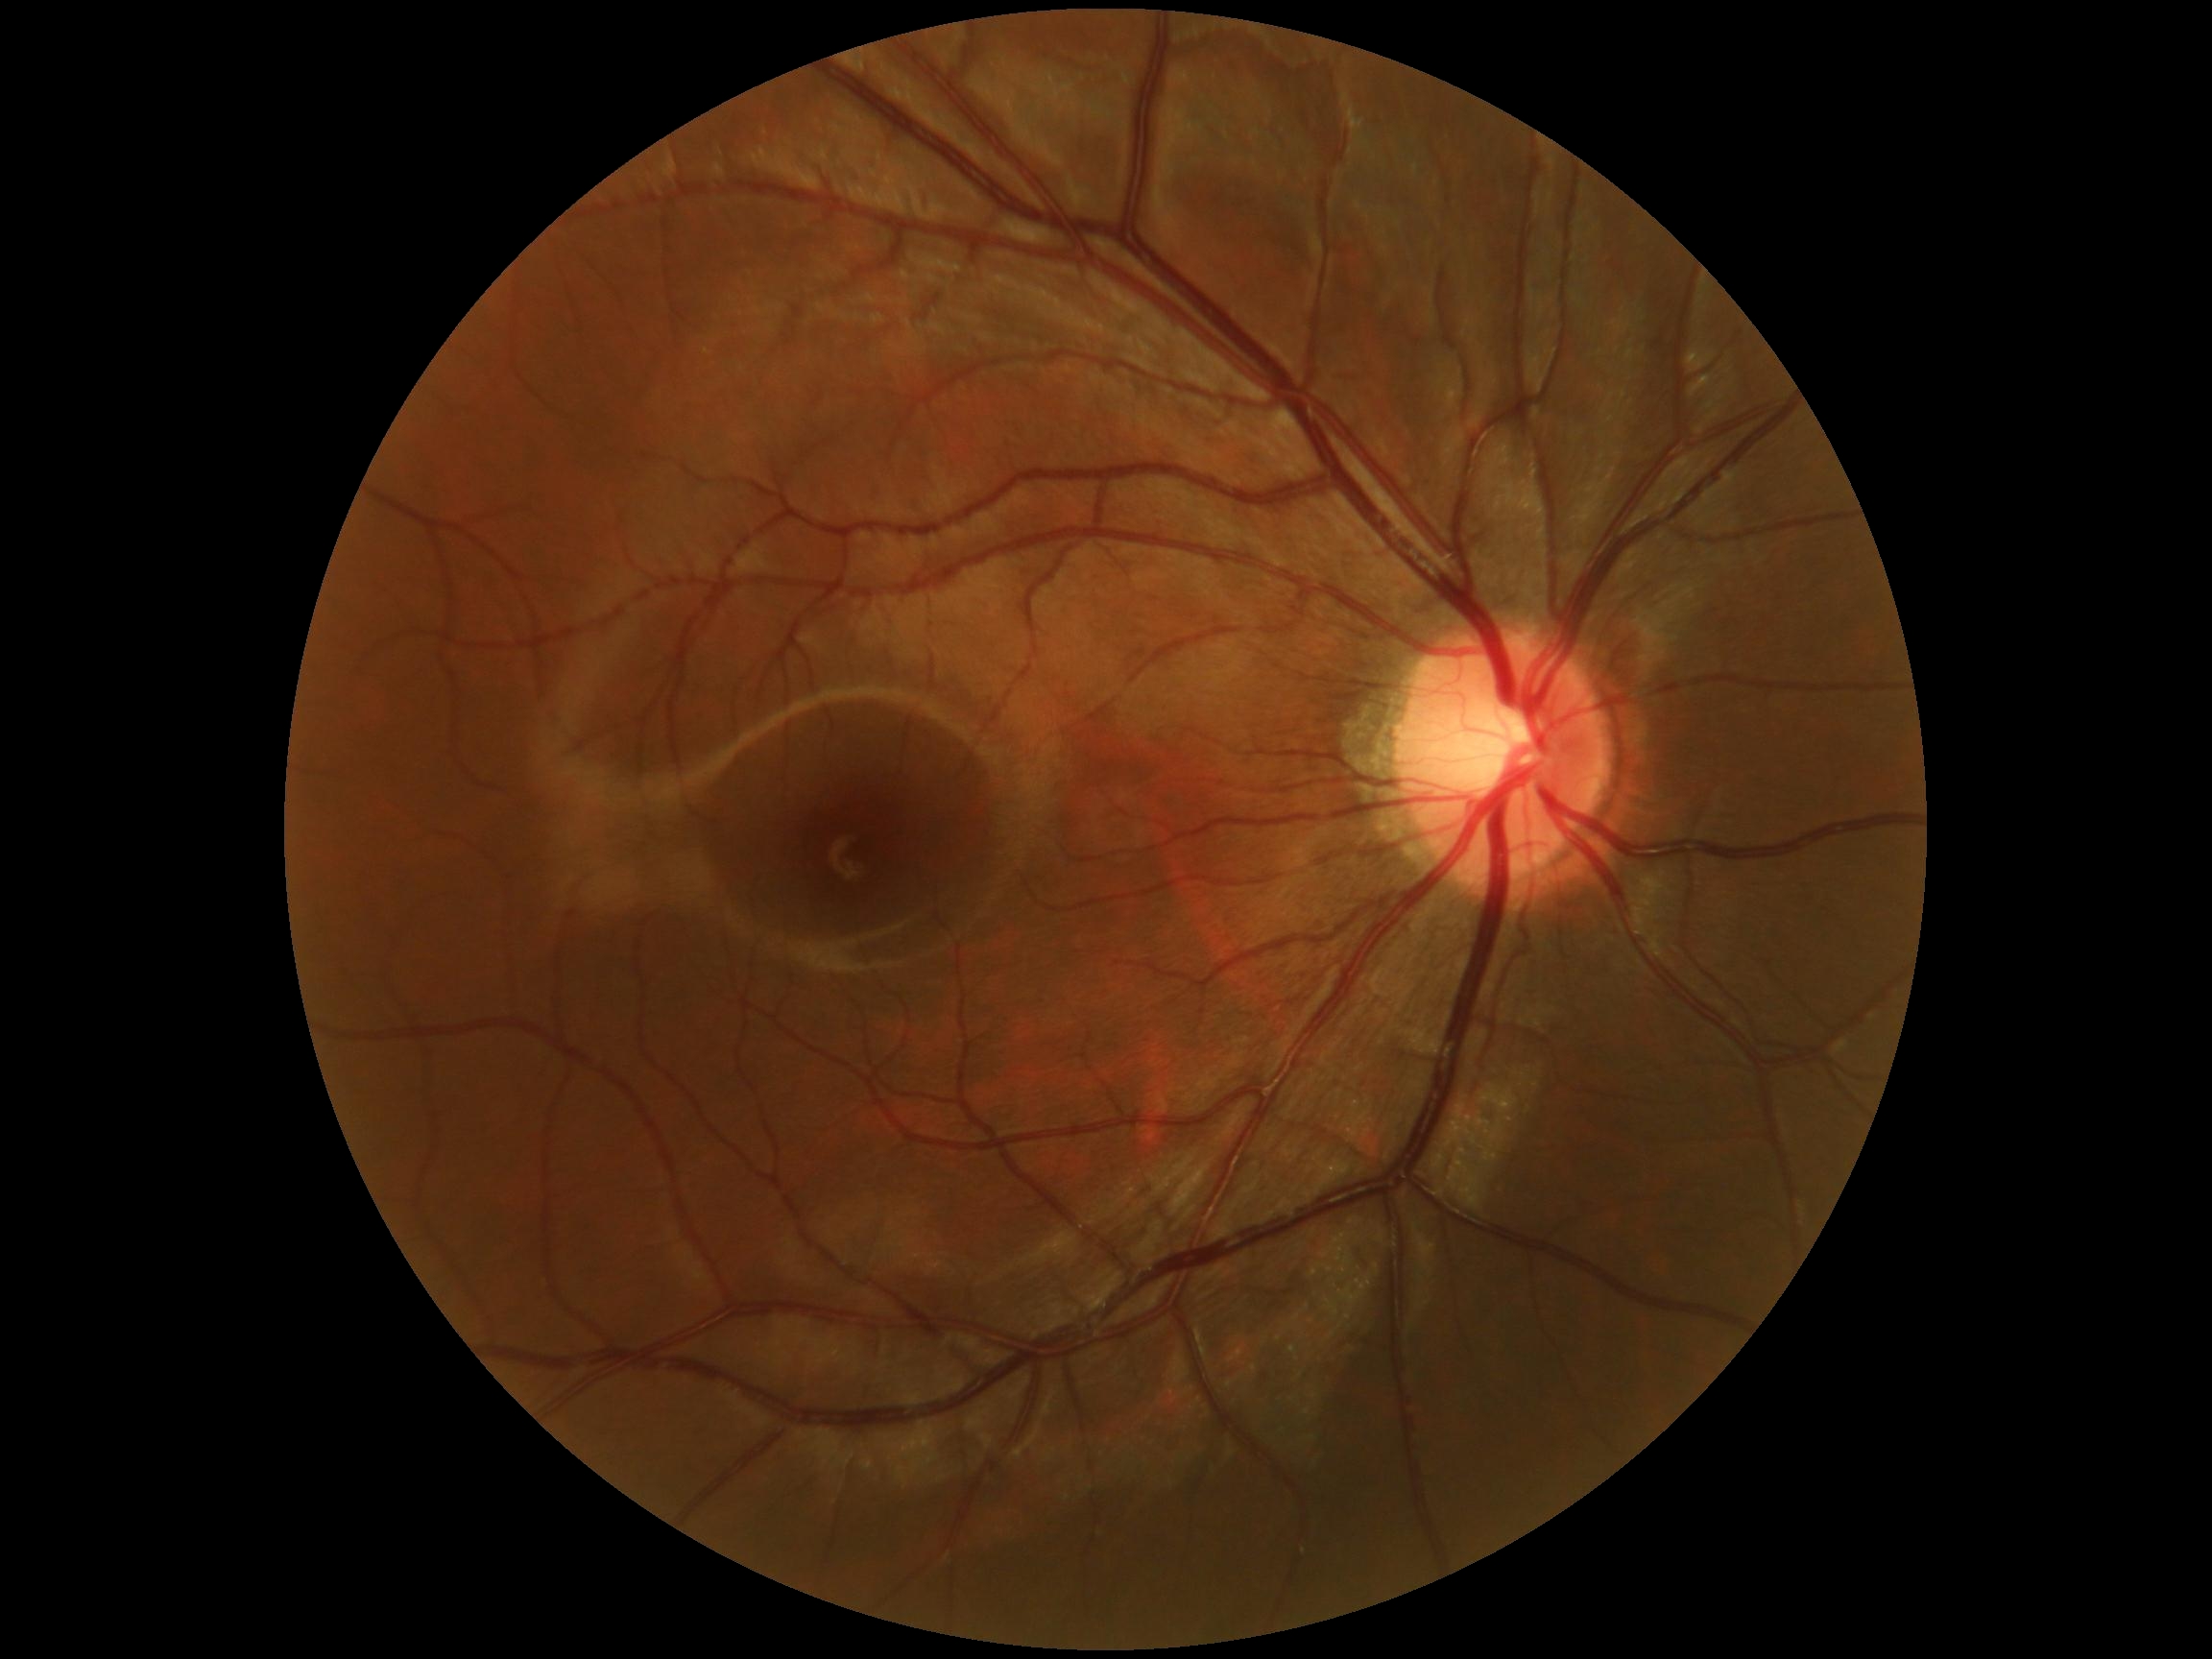

Diabetic retinopathy grade: 0 (no apparent retinopathy).